Camera: Clarity RetCam 3 (130° FOV). Wide-field contact fundus photograph of an infant:
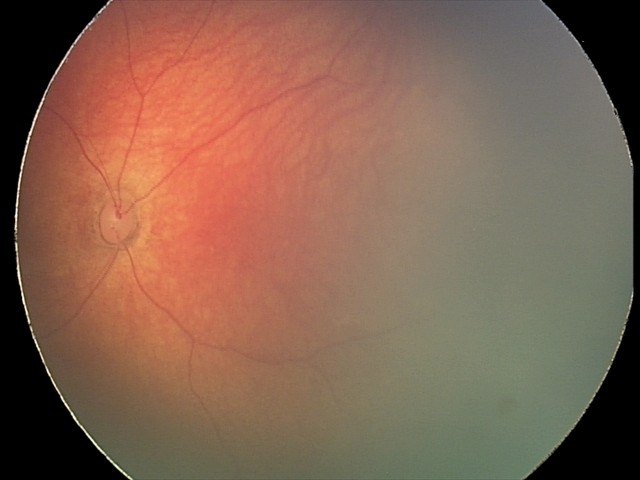
Diagnosis from this screening exam: retinal hemorrhages.